Pediatric wide-field fundus photograph — 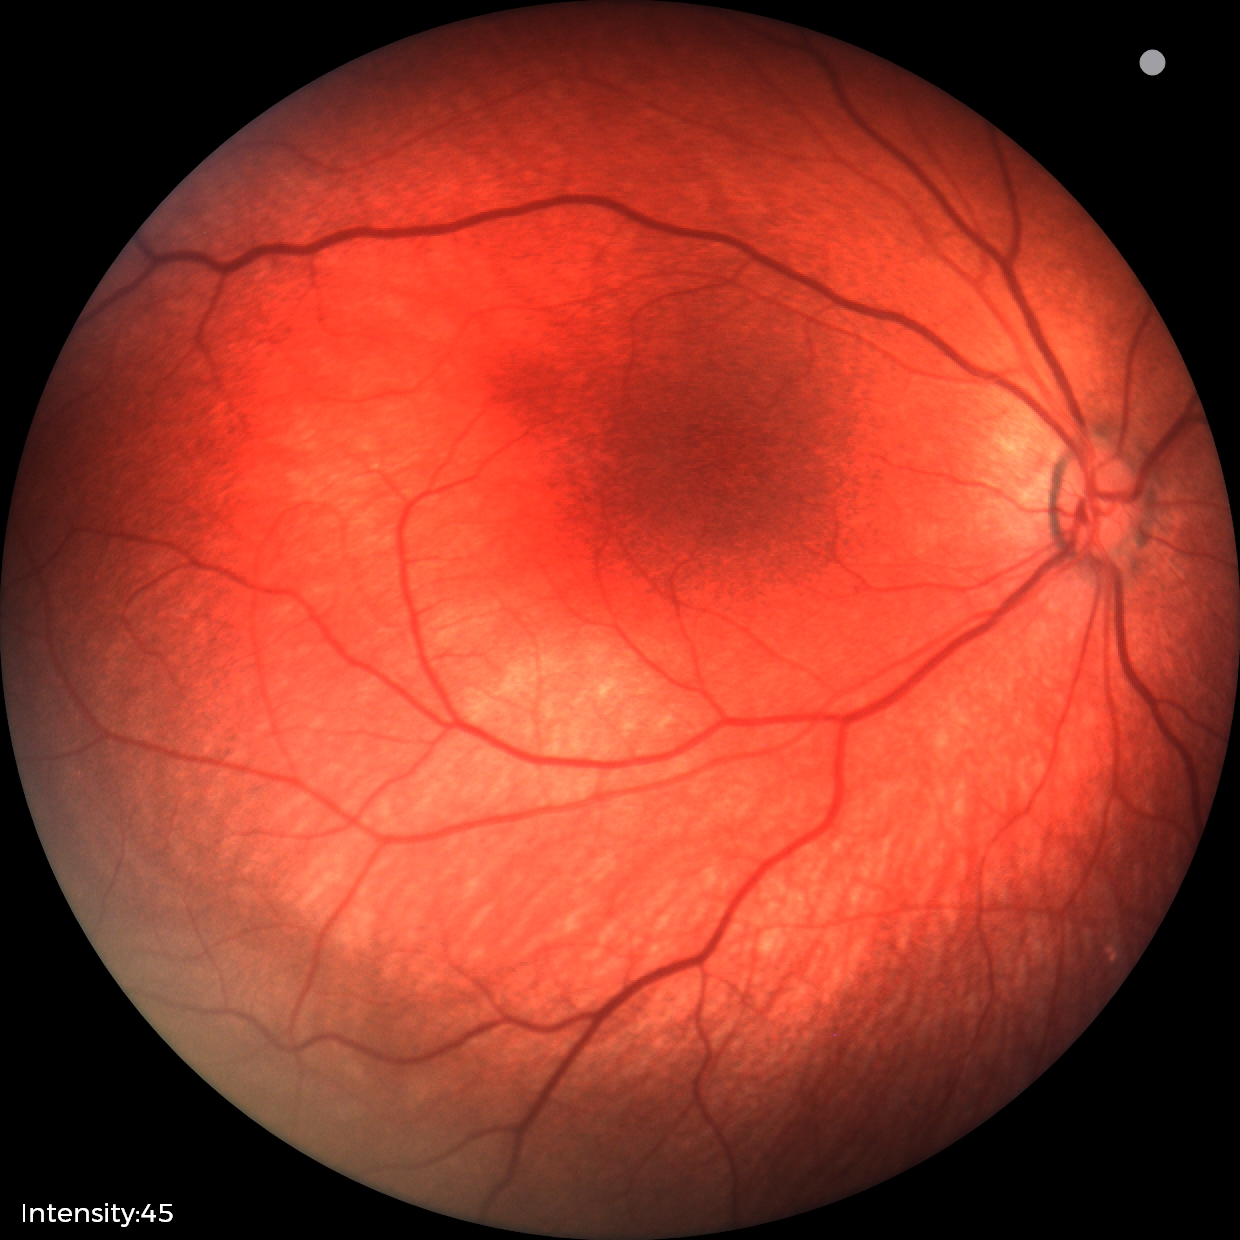 Examination with physiological retinal findings.